Wide-field fundus photograph from neonatal ROP screening
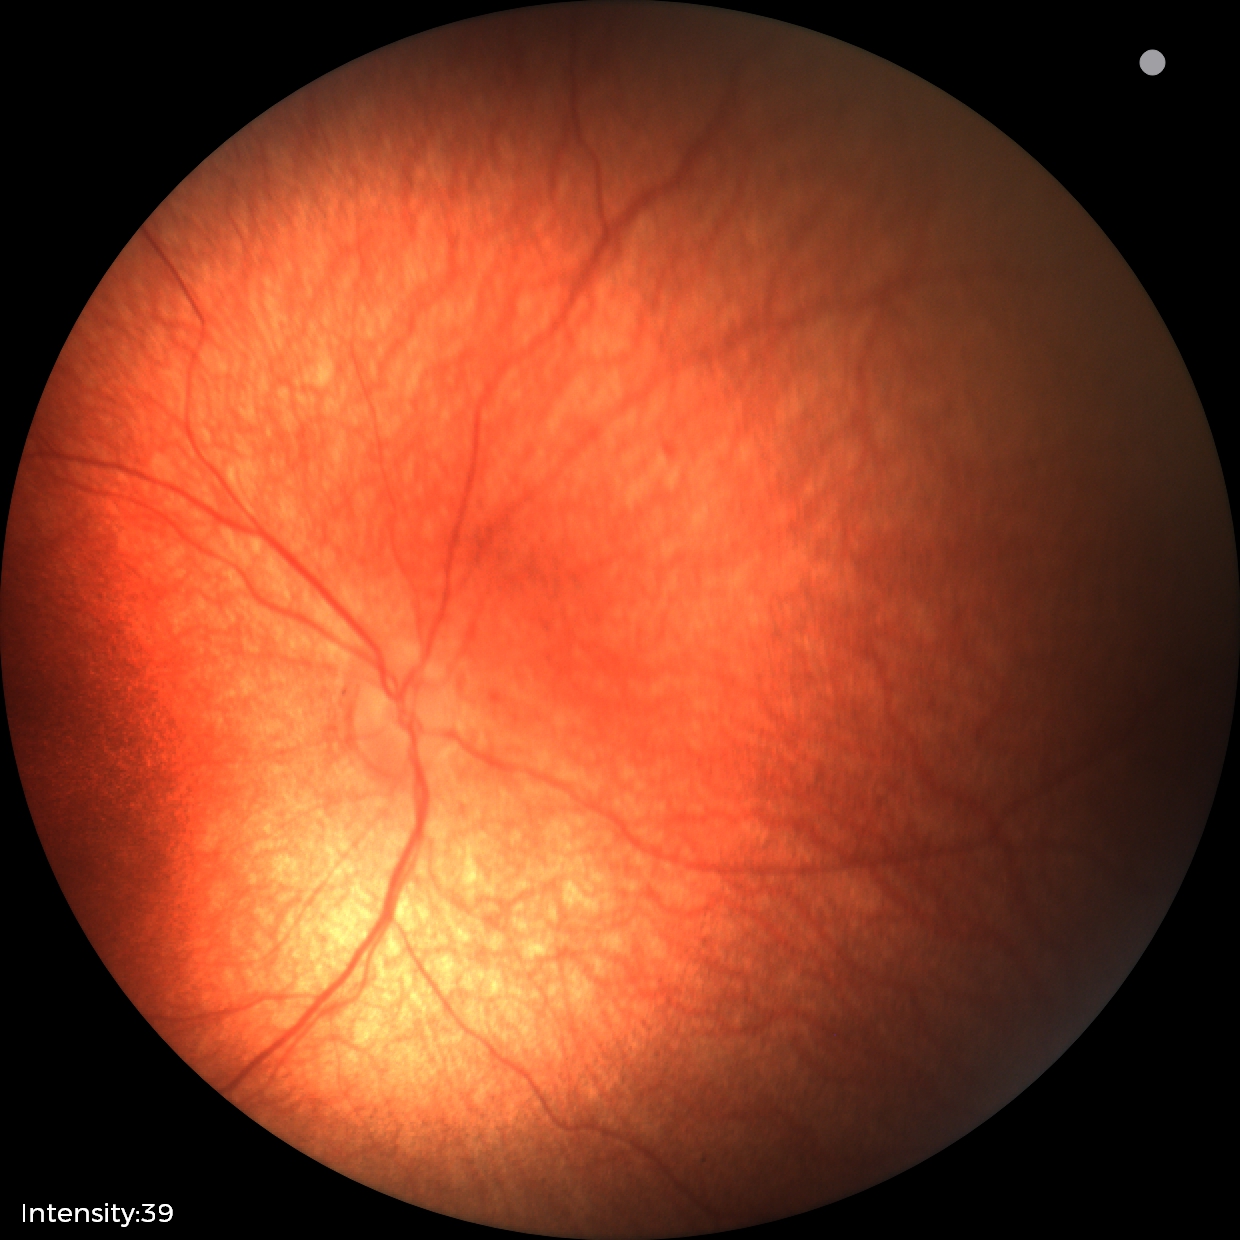 Physiological retinal appearance for postconceptual age.